Modified Davis classification; image size 848x848.
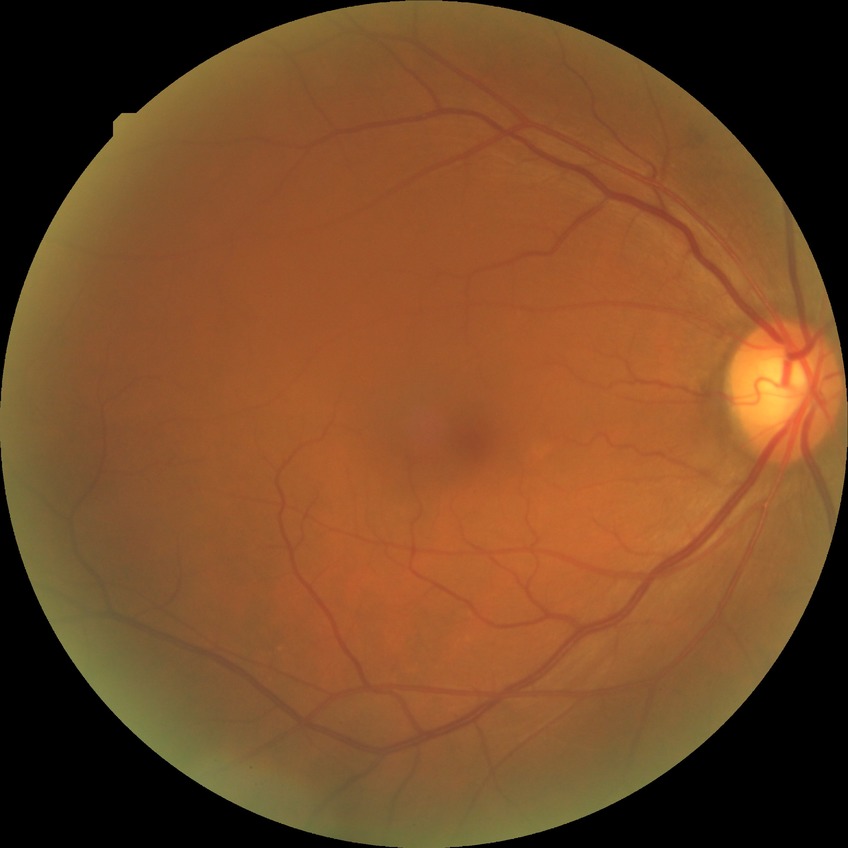 Findings:
* diabetic retinopathy severity — no diabetic retinopathy